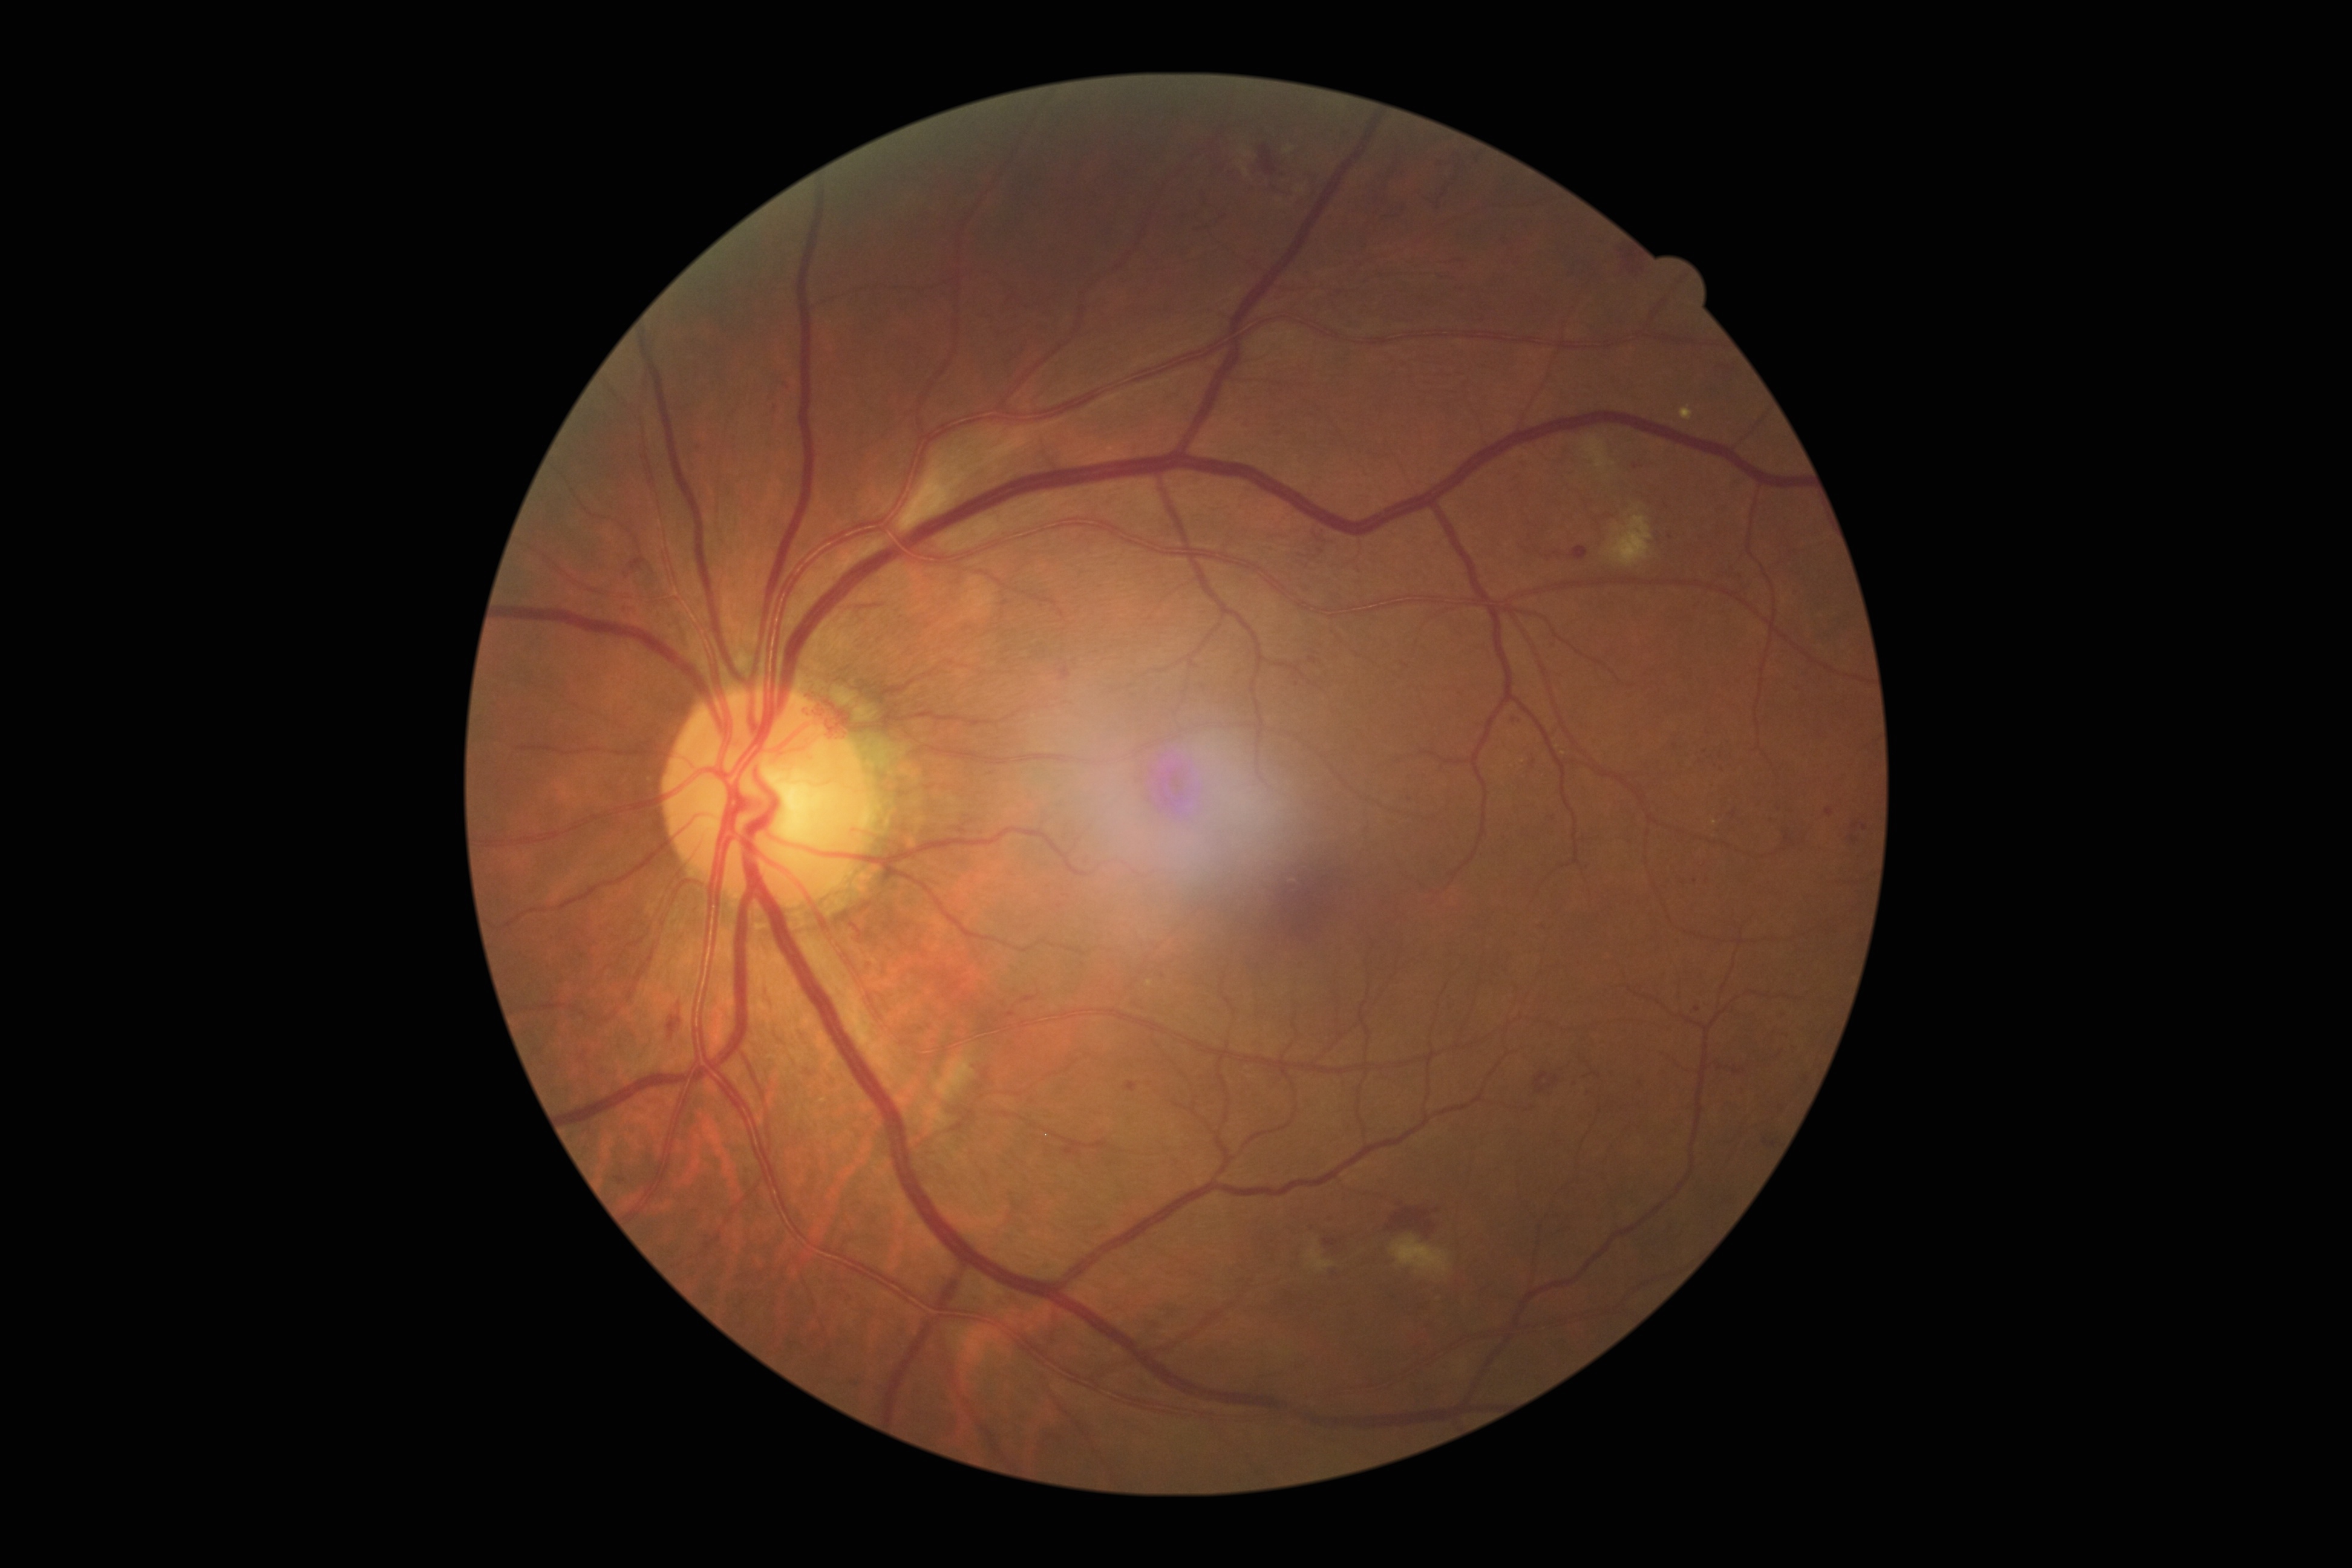

DR severity = moderate NPDR (grade 2) — more than just microaneurysms but less than severe NPDR